No pharmacologic dilation; 848 by 848 pixels; 45 degree fundus photograph; camera: NIDEK AFC-230; CFP:
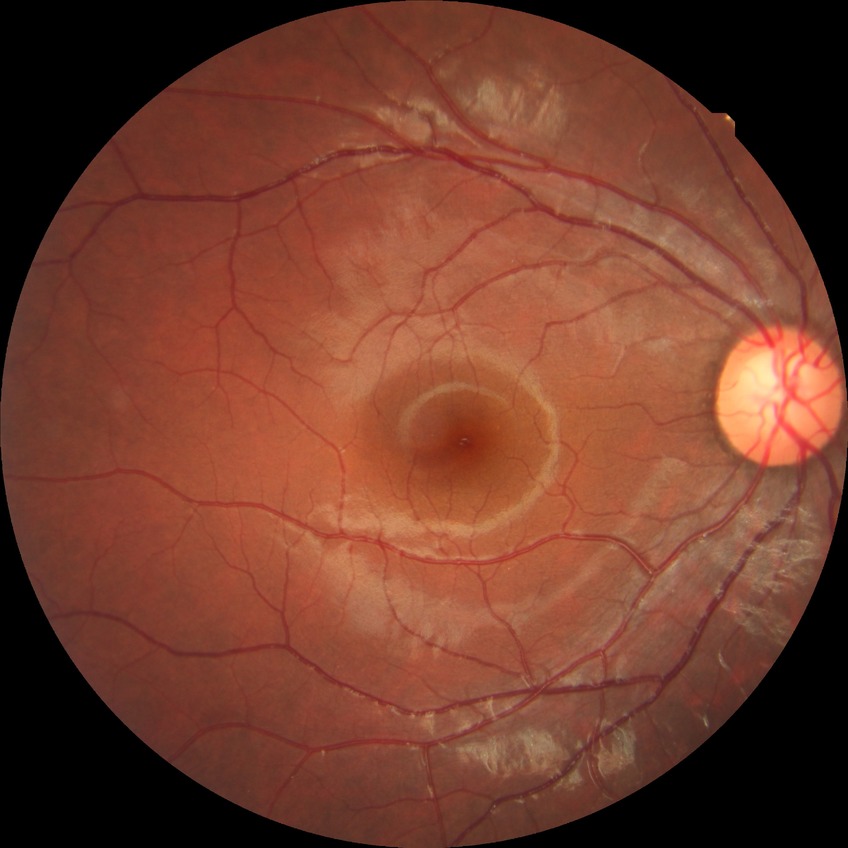 Diabetic retinopathy (DR) is NDR (no diabetic retinopathy).